Wide-field fundus photograph from neonatal ROP screening; Natus RetCam Envision, 130° FOV.
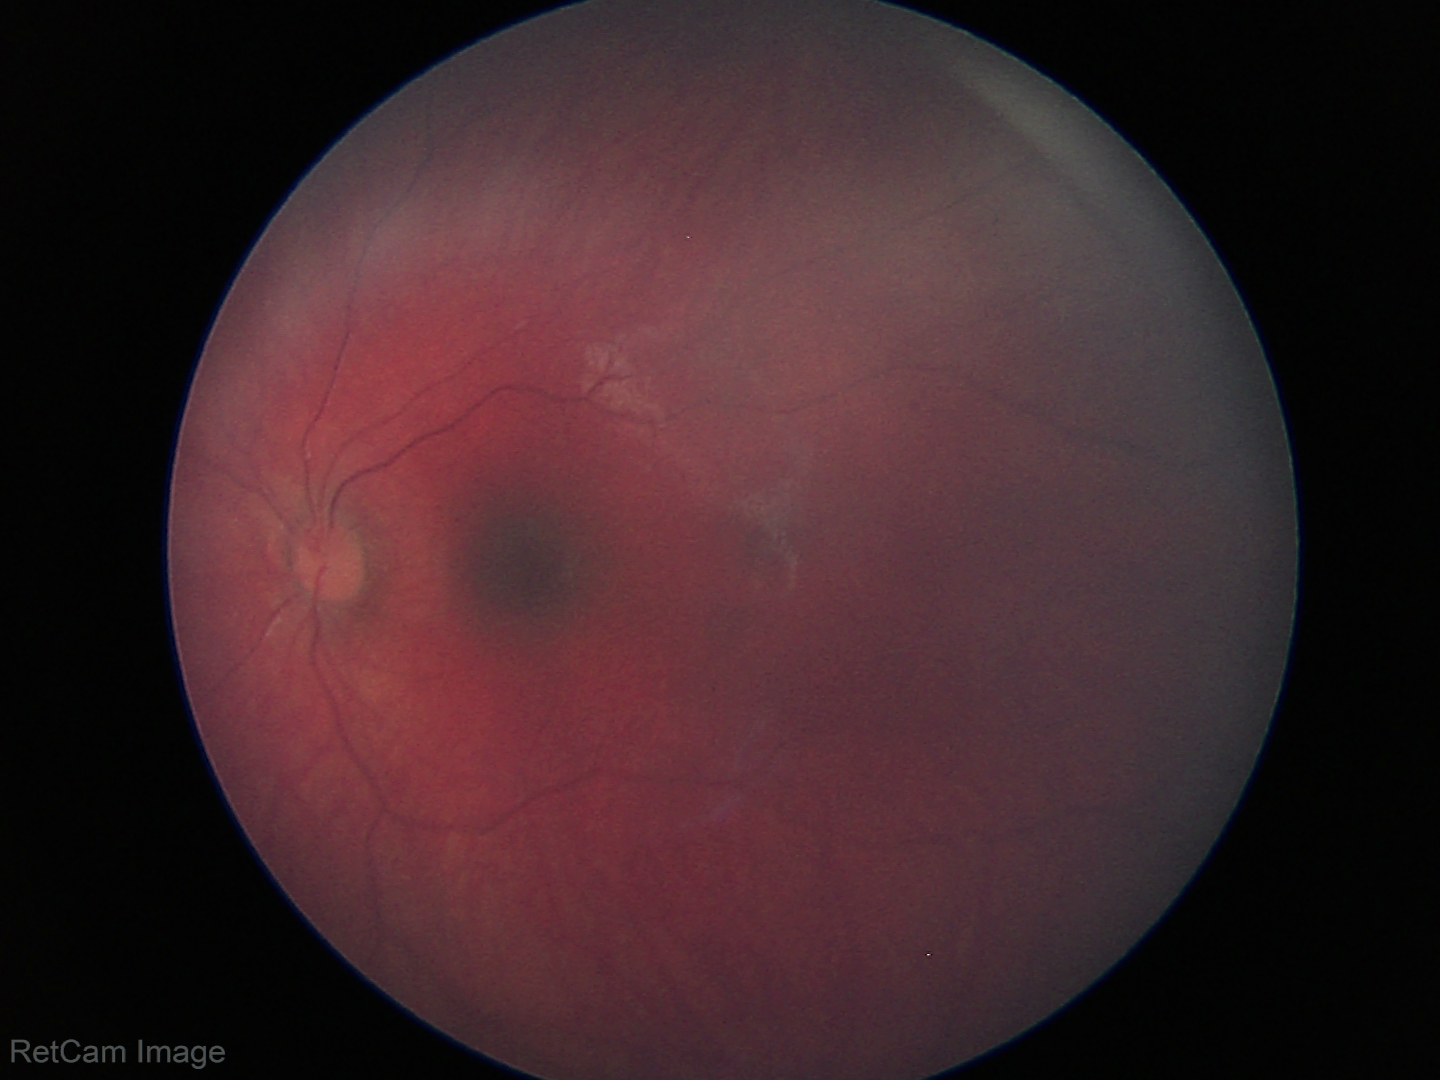 Physiological retinal appearance for postconceptual age.